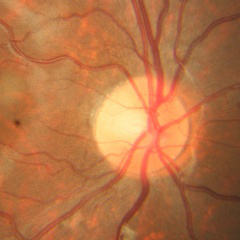
Glaucoma assessment: no glaucomatous findings.